Color fundus image · non-mydriatic acquisition:
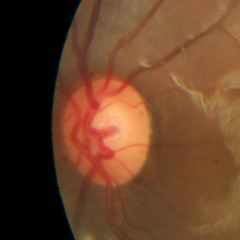
Showing no signs of glaucoma.